Color fundus photograph — 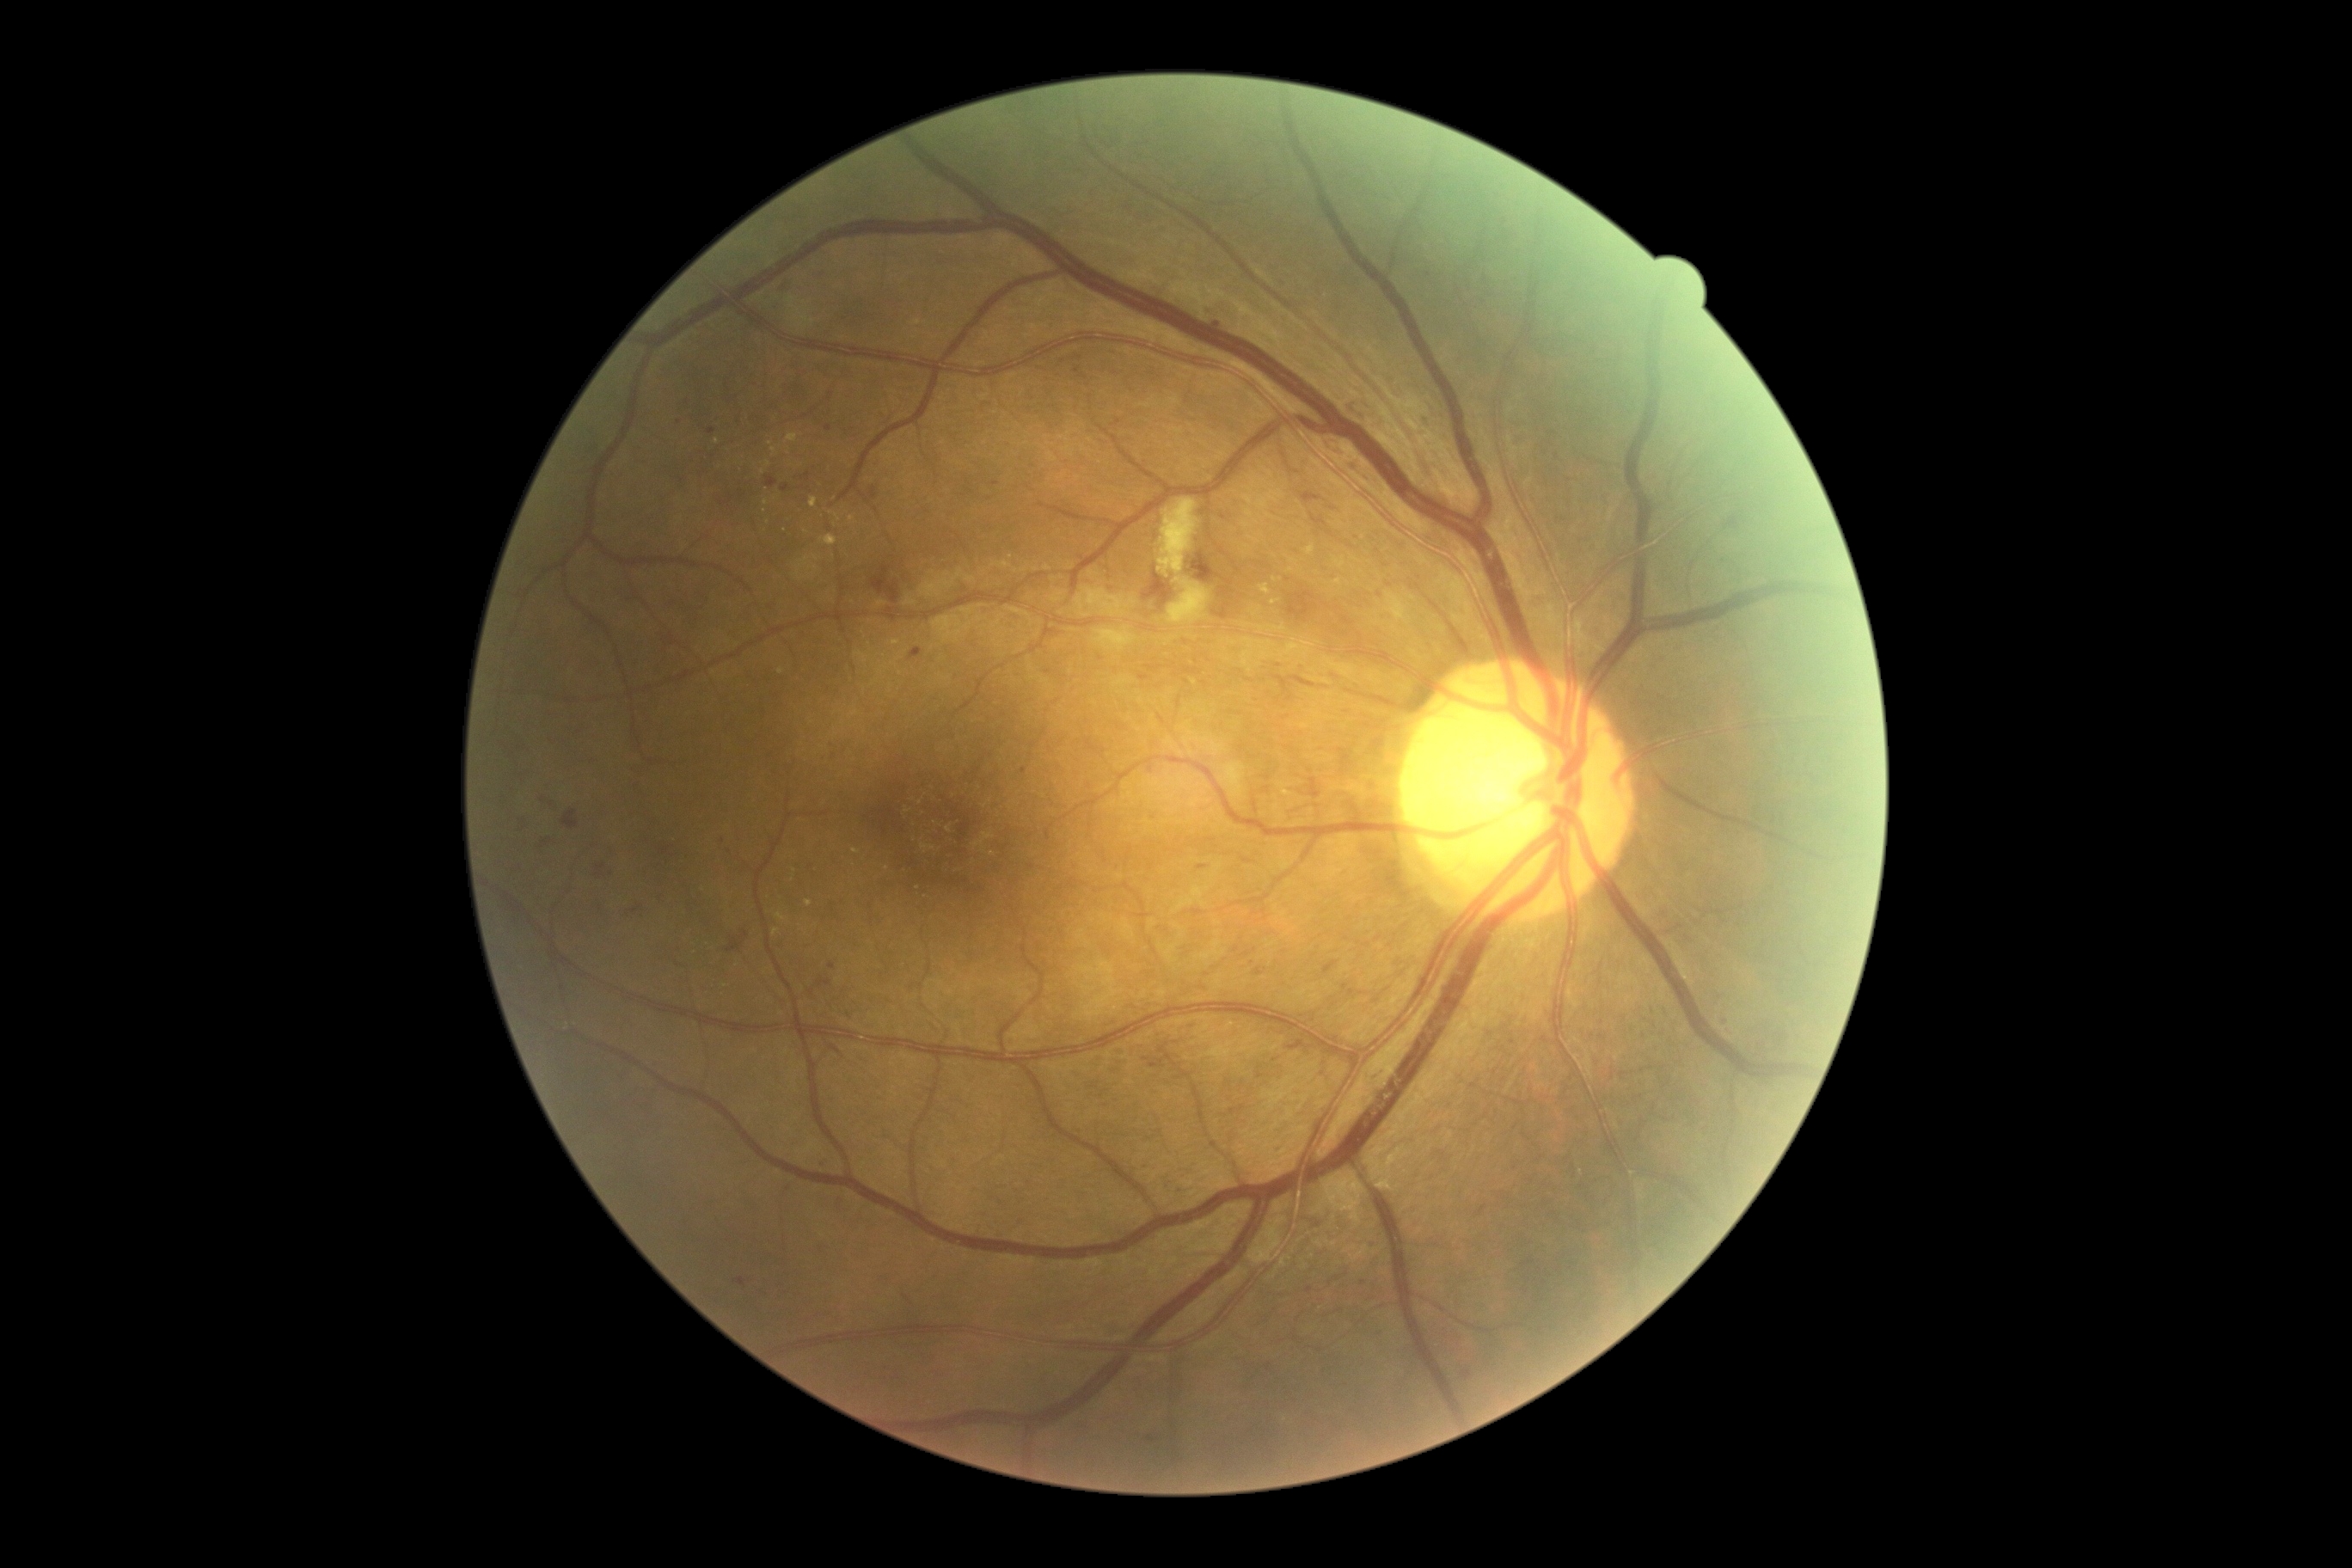 Retinopathy grade: 2/4
Selected lesions:
microaneurysms (partial): BBox(1148, 1436, 1158, 1443) | BBox(742, 931, 749, 940) | BBox(1478, 1206, 1486, 1216) | BBox(1213, 321, 1220, 329) | BBox(1149, 1062, 1167, 1070) | BBox(1522, 1261, 1534, 1266) | BBox(869, 487, 878, 499) | BBox(1323, 962, 1338, 974)
Additional small microaneurysms near point(1363, 1283) | point(994, 484) | point(1725, 1020) | point(829, 429) | point(1024, 772) | point(729, 853) | point(1146, 1060) | point(546, 843)